Retinal fundus photograph · 45-degree field of view: 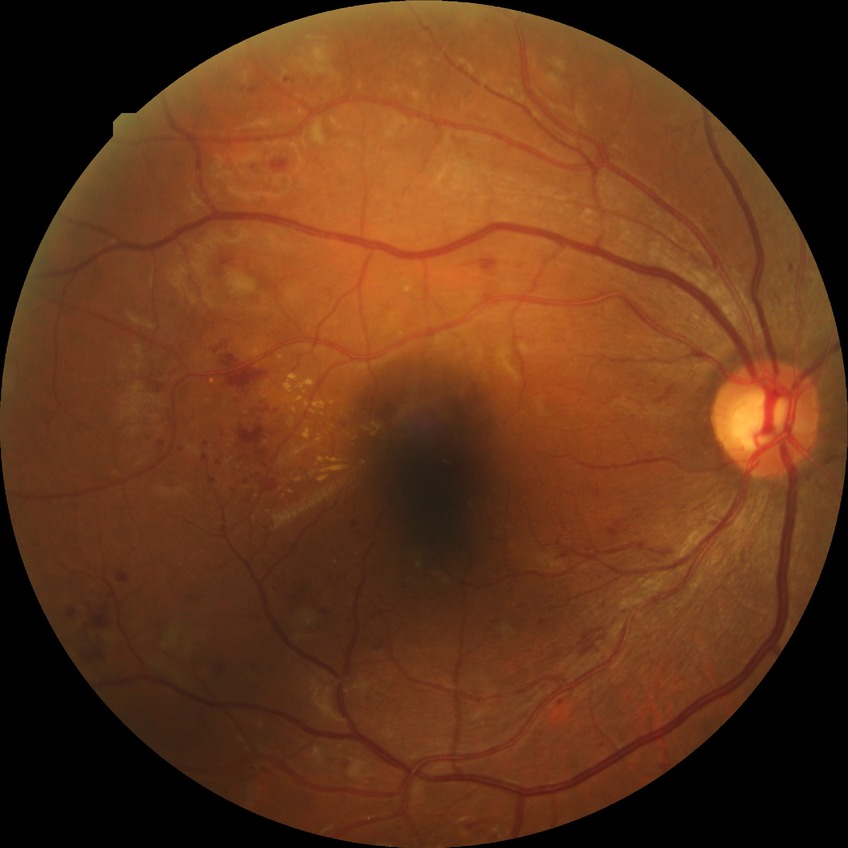

Diabetic retinopathy grade is pre-proliferative diabetic retinopathy.